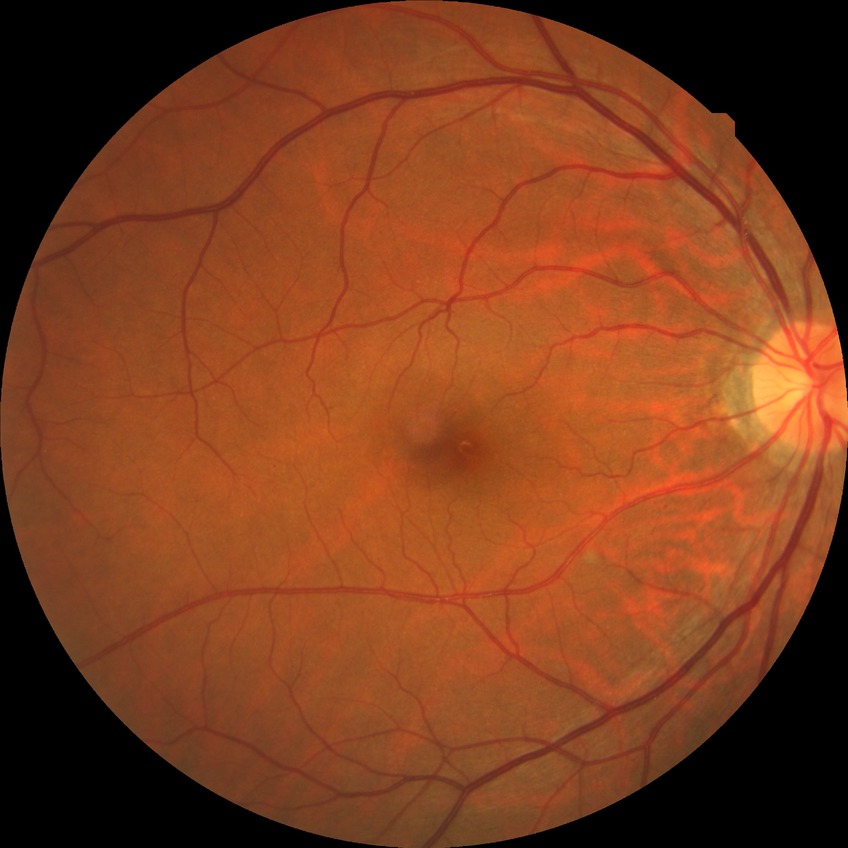 diabetic retinopathy (DR): SDR (simple diabetic retinopathy).